Topcon TRC retinal camera, IMAGEnet capture system · fundus image cropped to the optic disc — 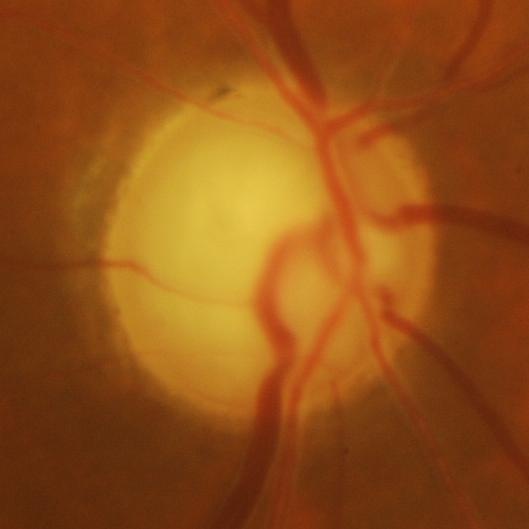

Glaucomatous changes are present. Optic disc appearance consistent with glaucomatous damage to the optic nerve.